Wide-field contact fundus photograph of an infant — 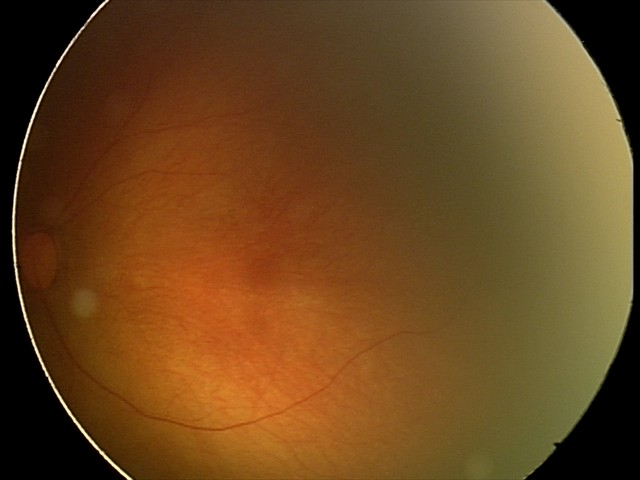 Screening examination with no abnormal retinal findings.